2184x1690. CFP. 45° FOV: 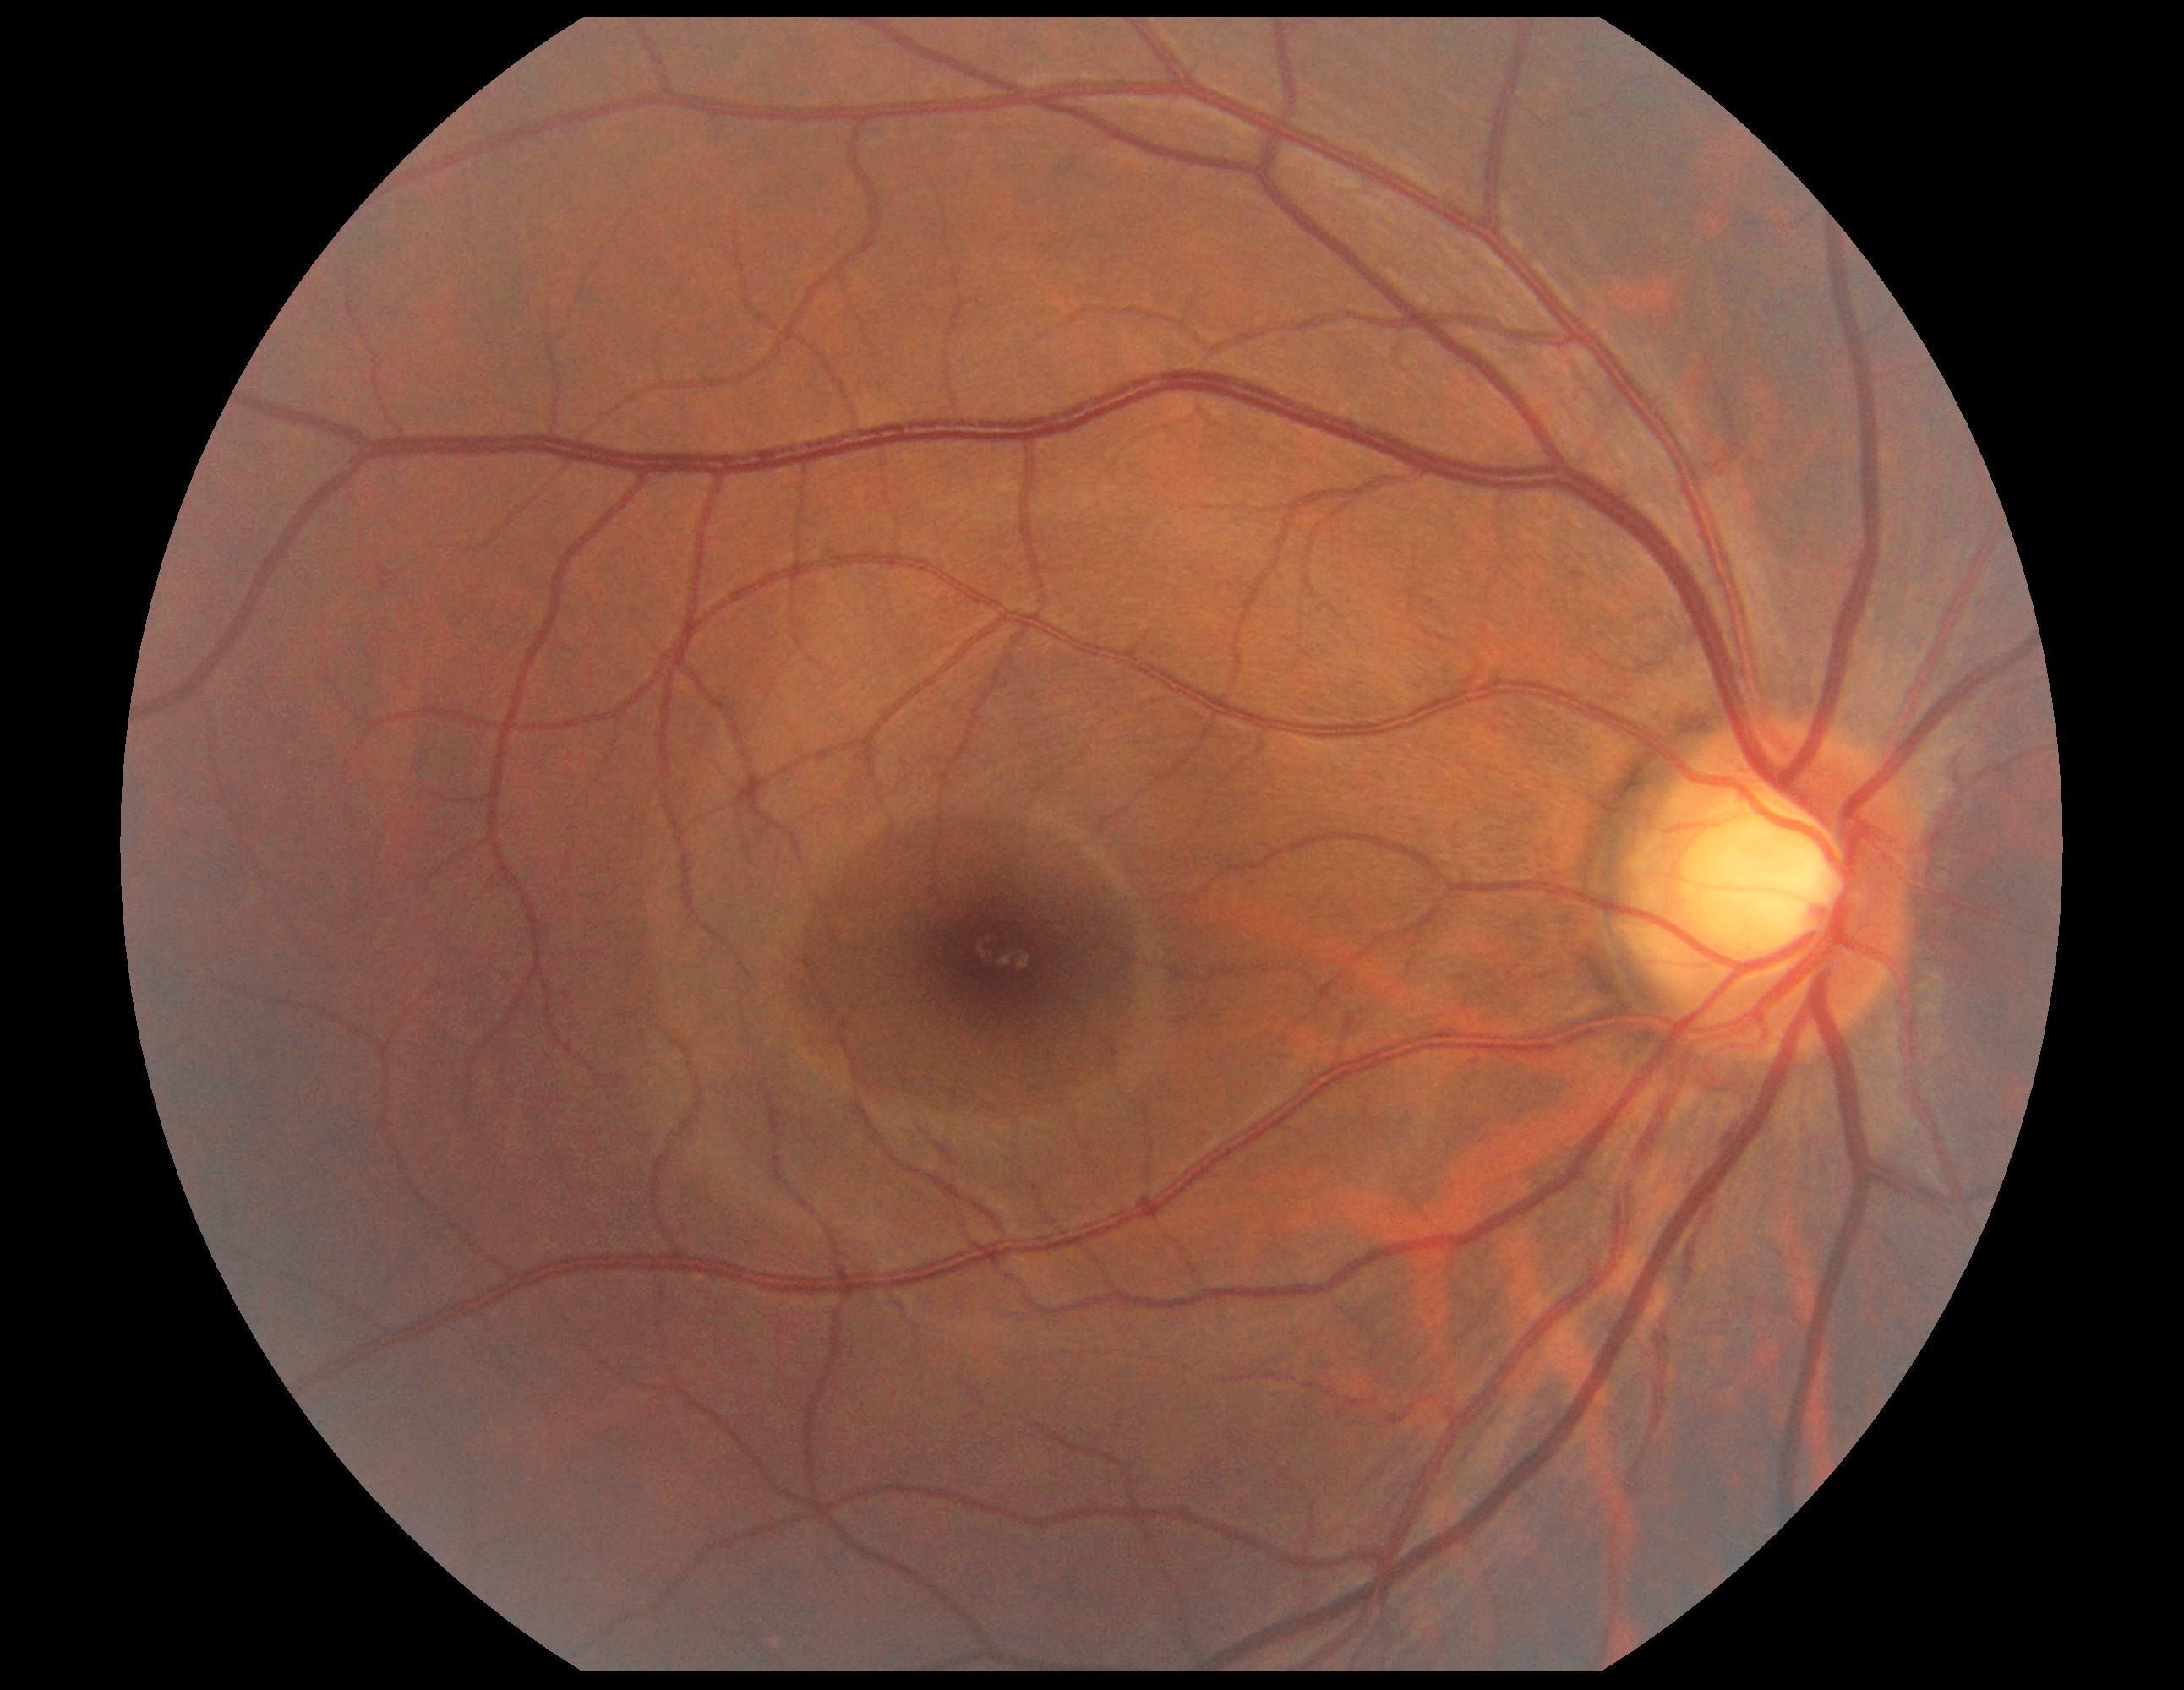

diabetic retinopathy (DR)@no apparent diabetic retinopathy (grade 0).